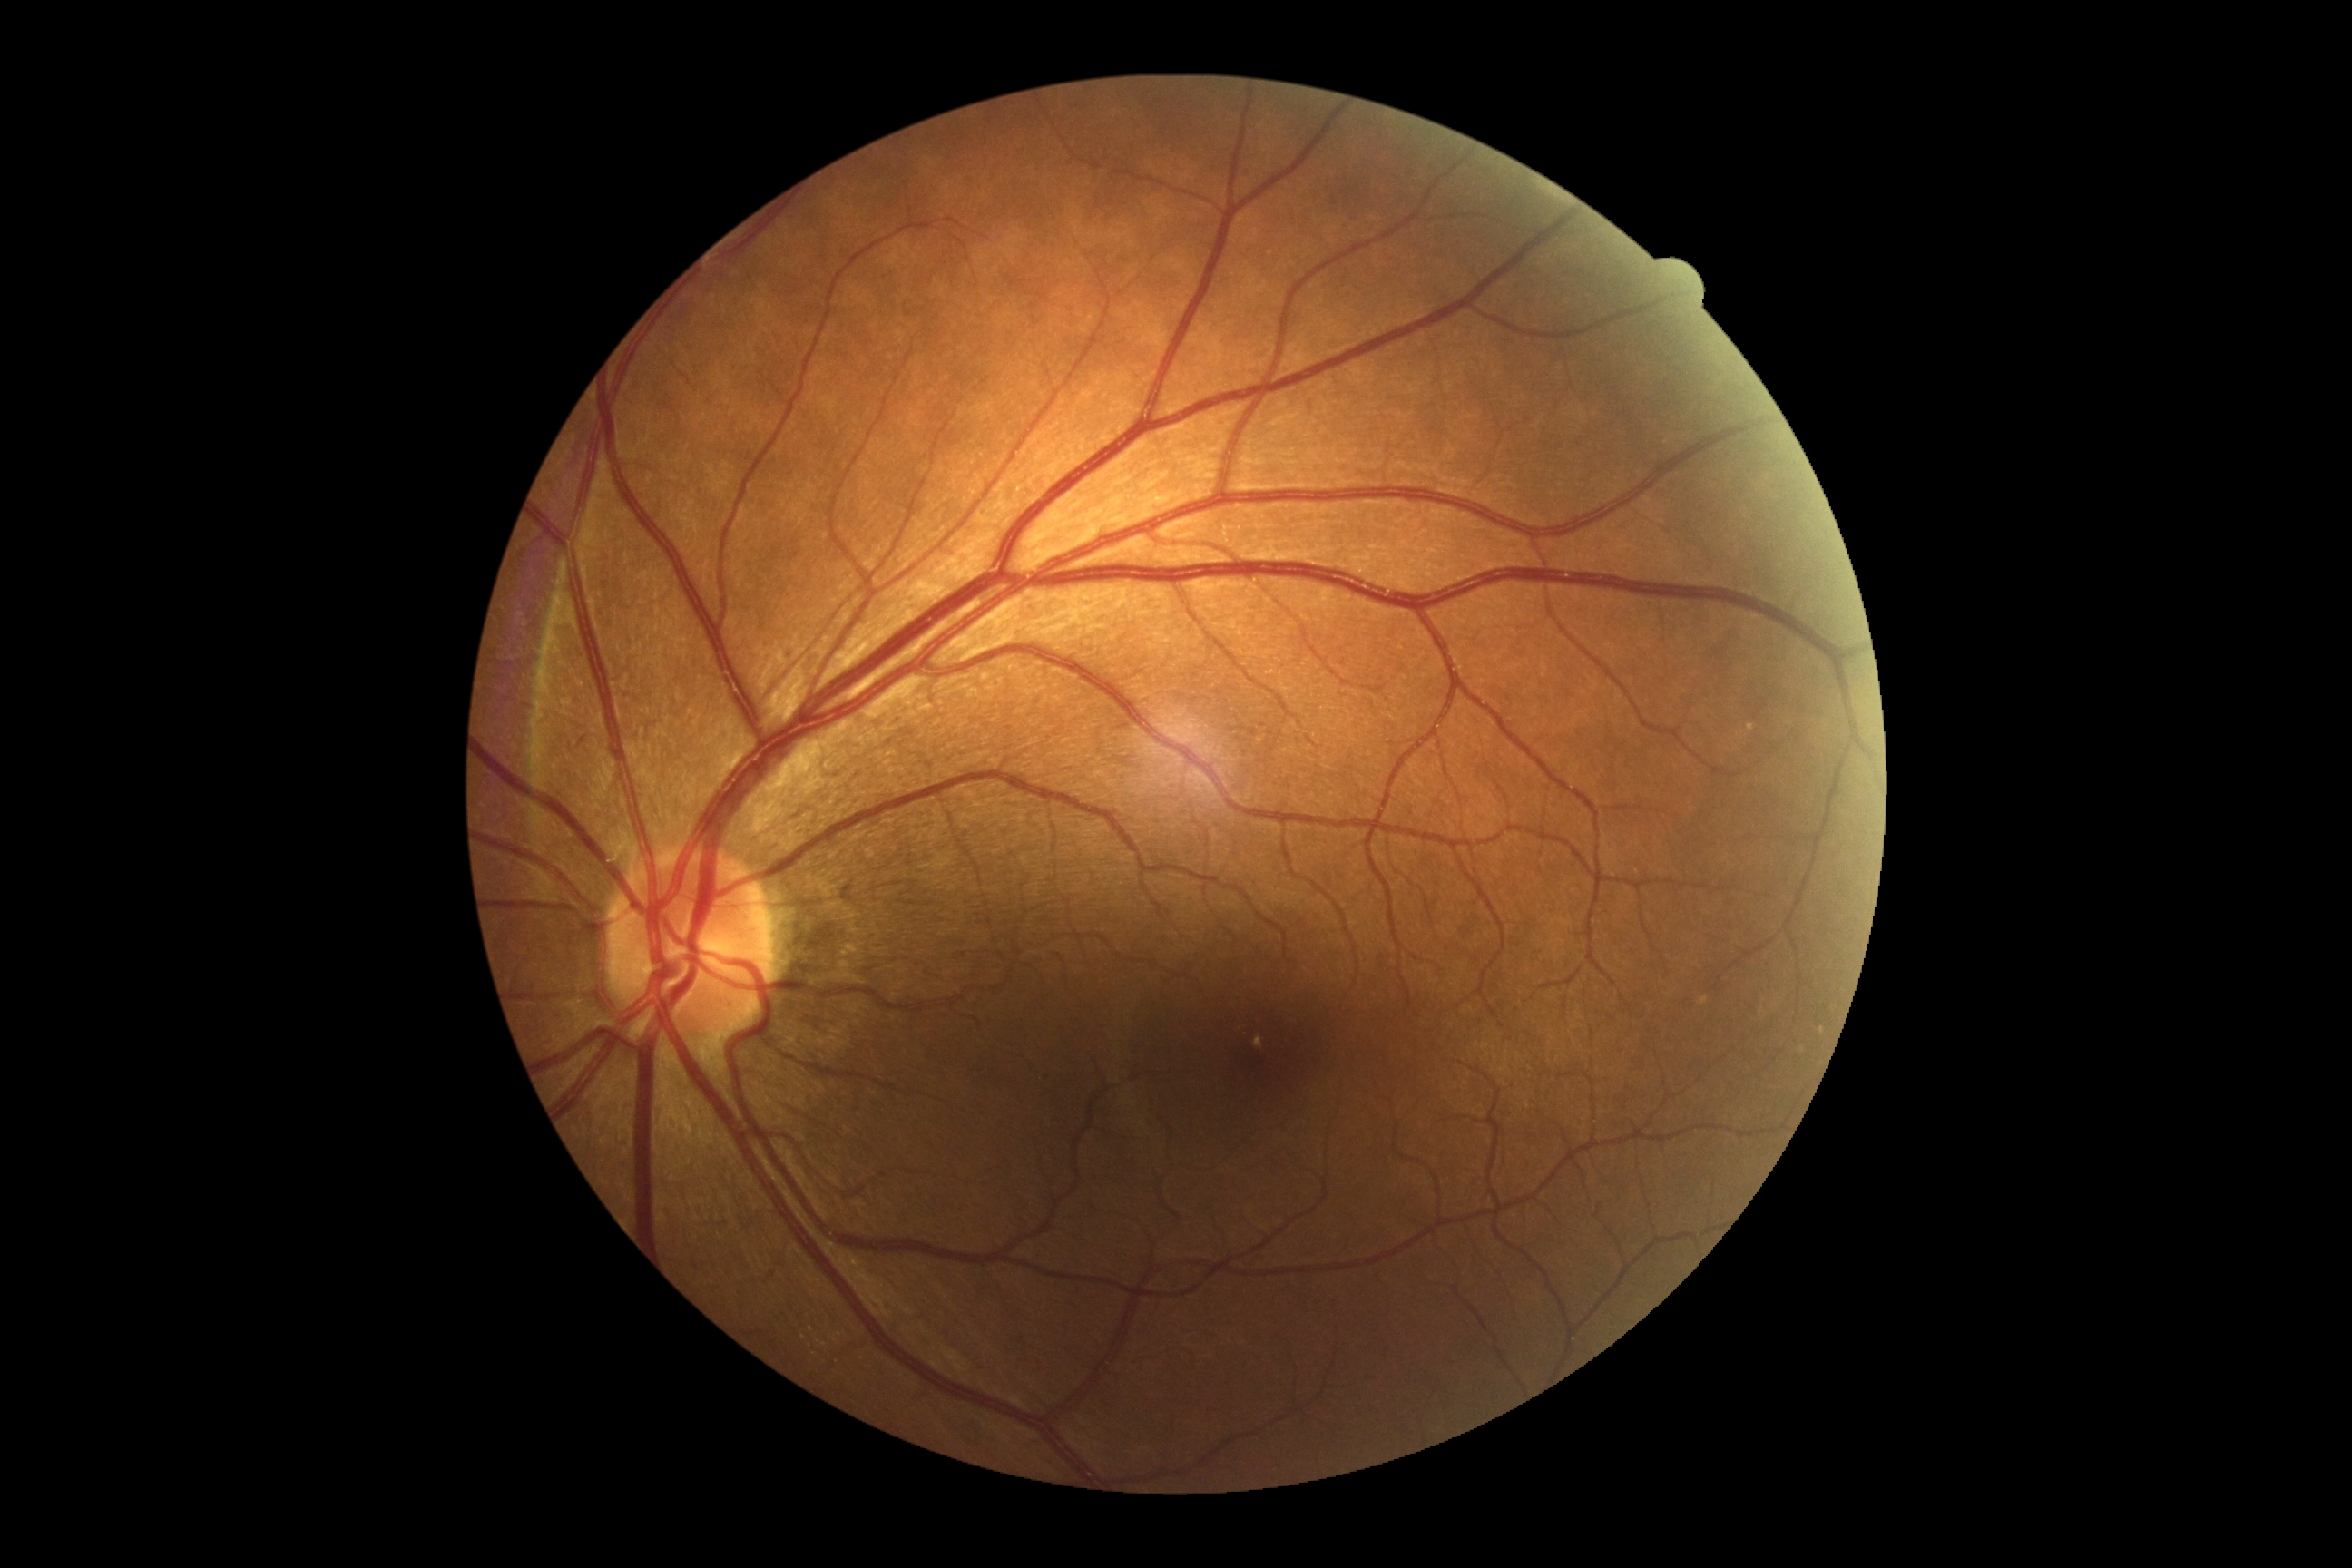

Diabetic retinopathy (DR) is no apparent diabetic retinopathy (grade 0). No apparent diabetic retinopathy.